Posterior pole view
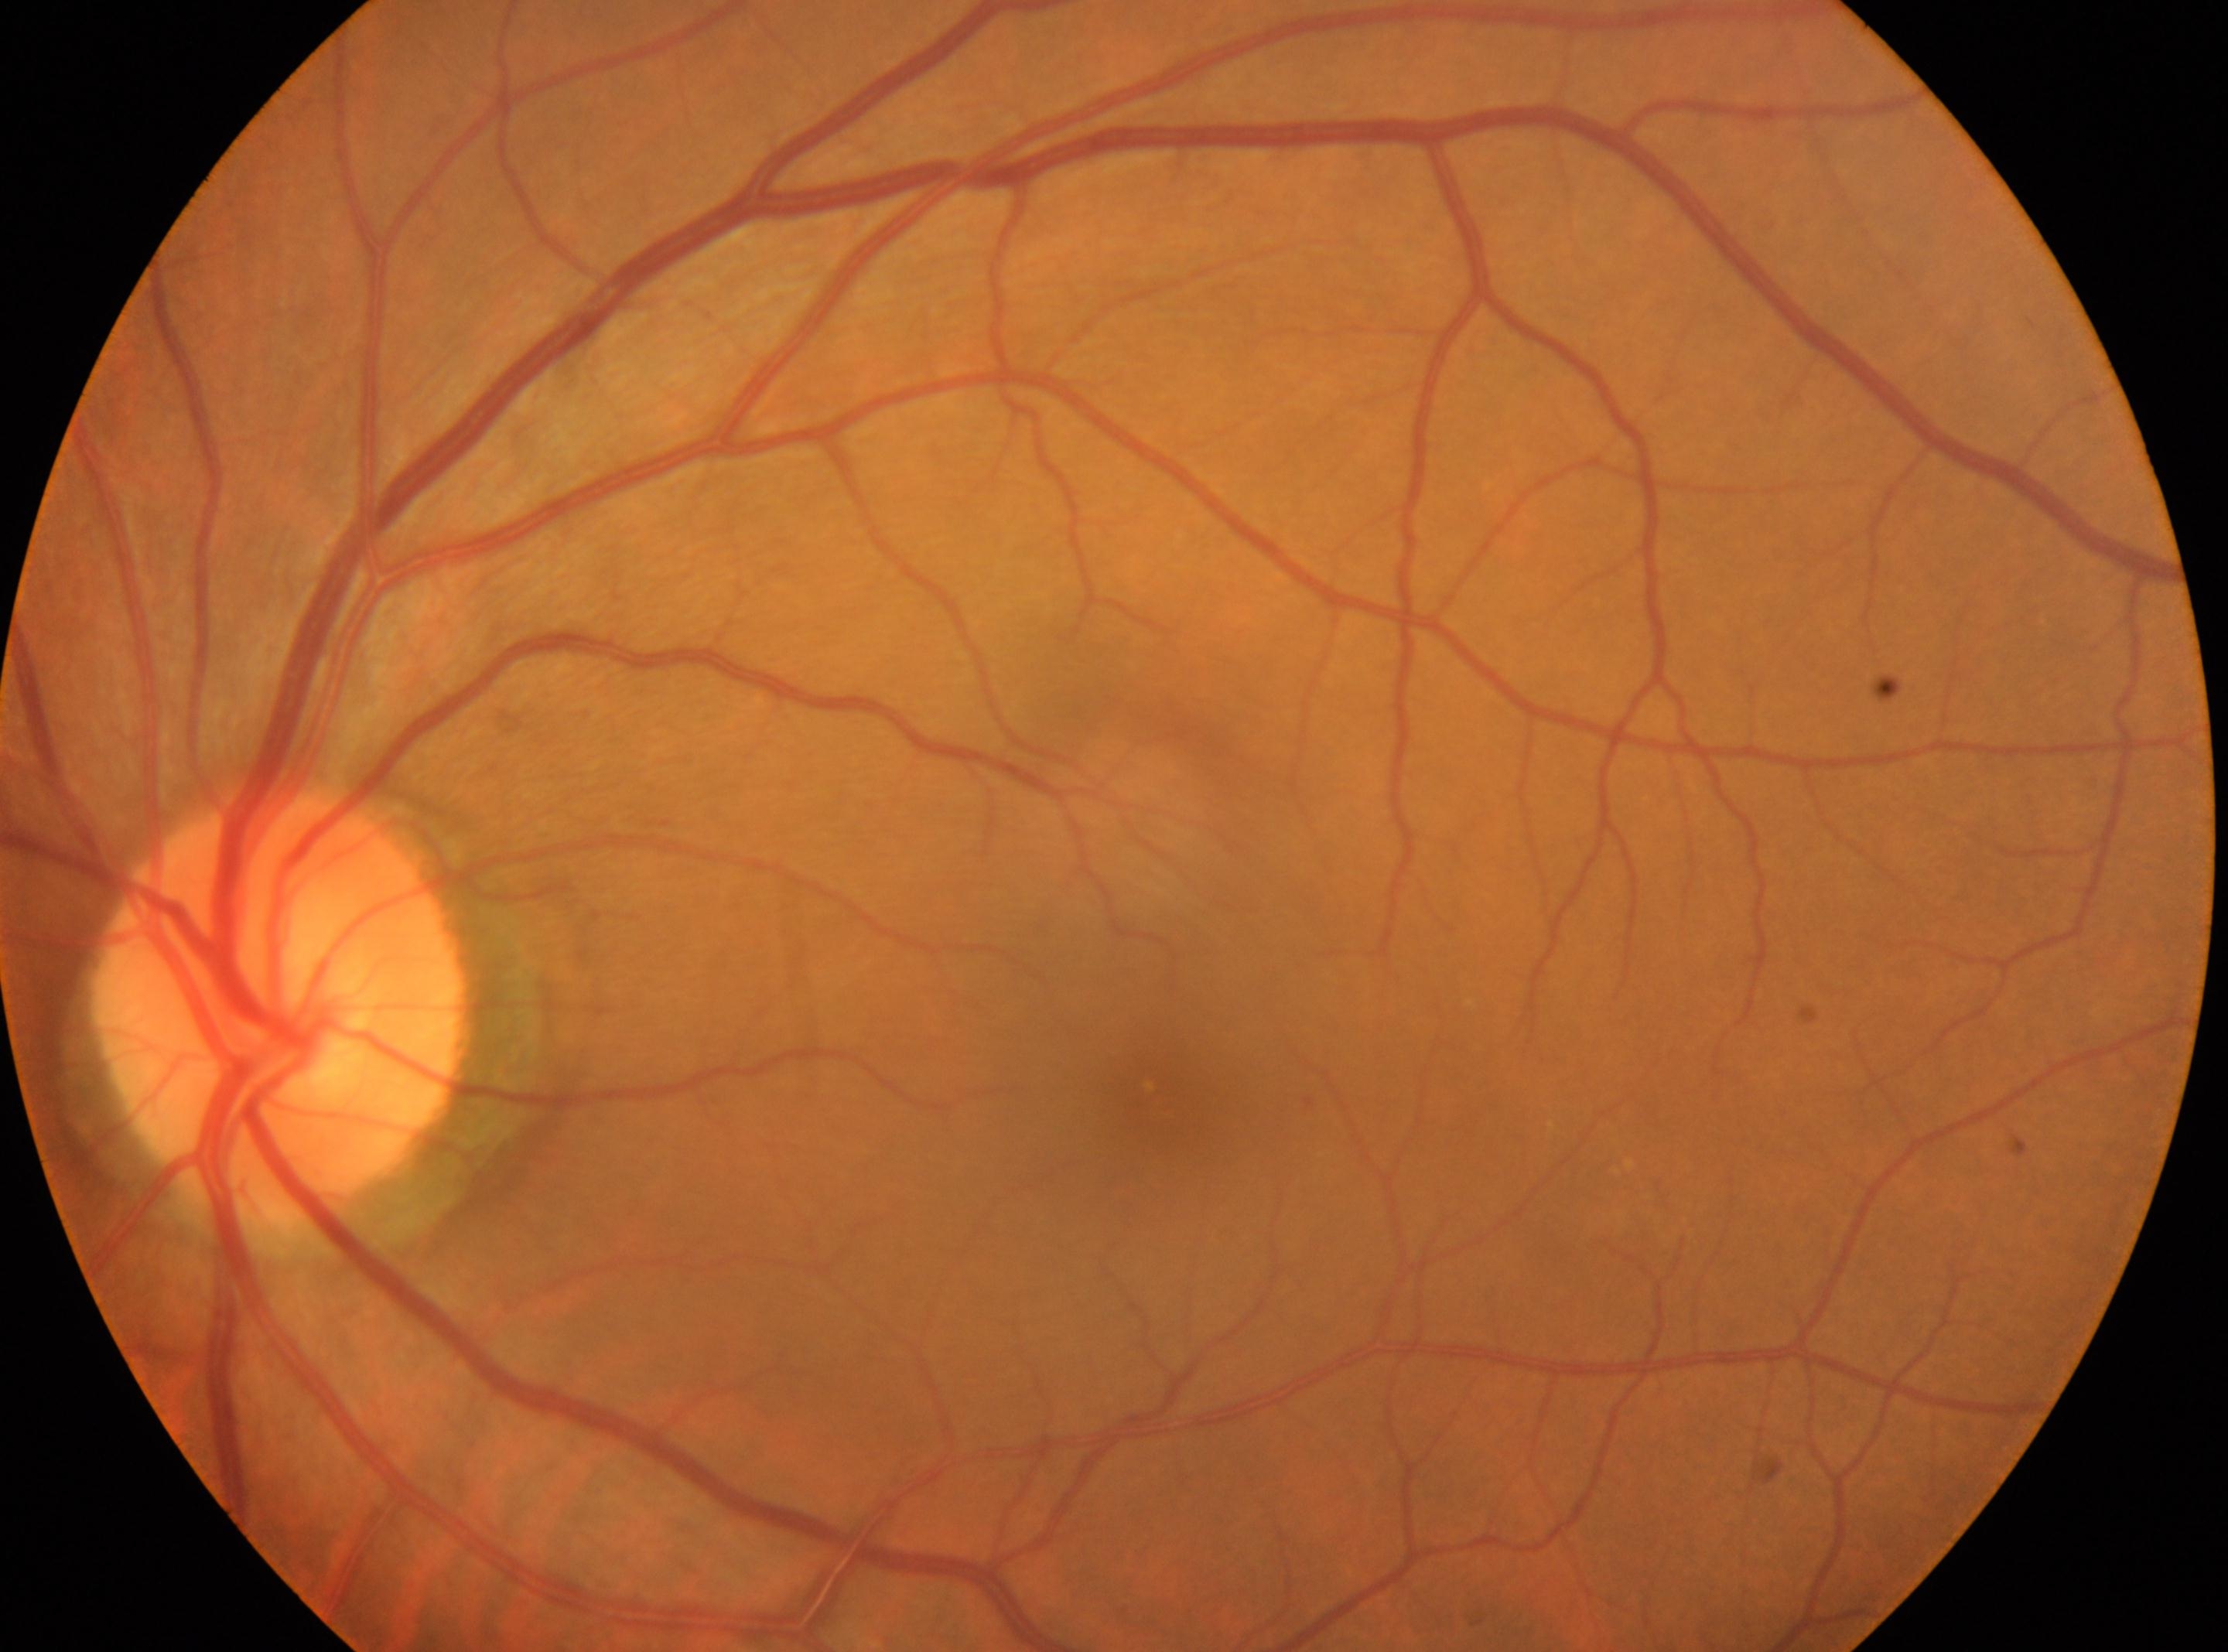

DR severity: grade 1 (mild NPDR).
Macular center: (x=1157, y=1100).
Optic nerve head located at (x=280, y=1007).
Eye: OS.